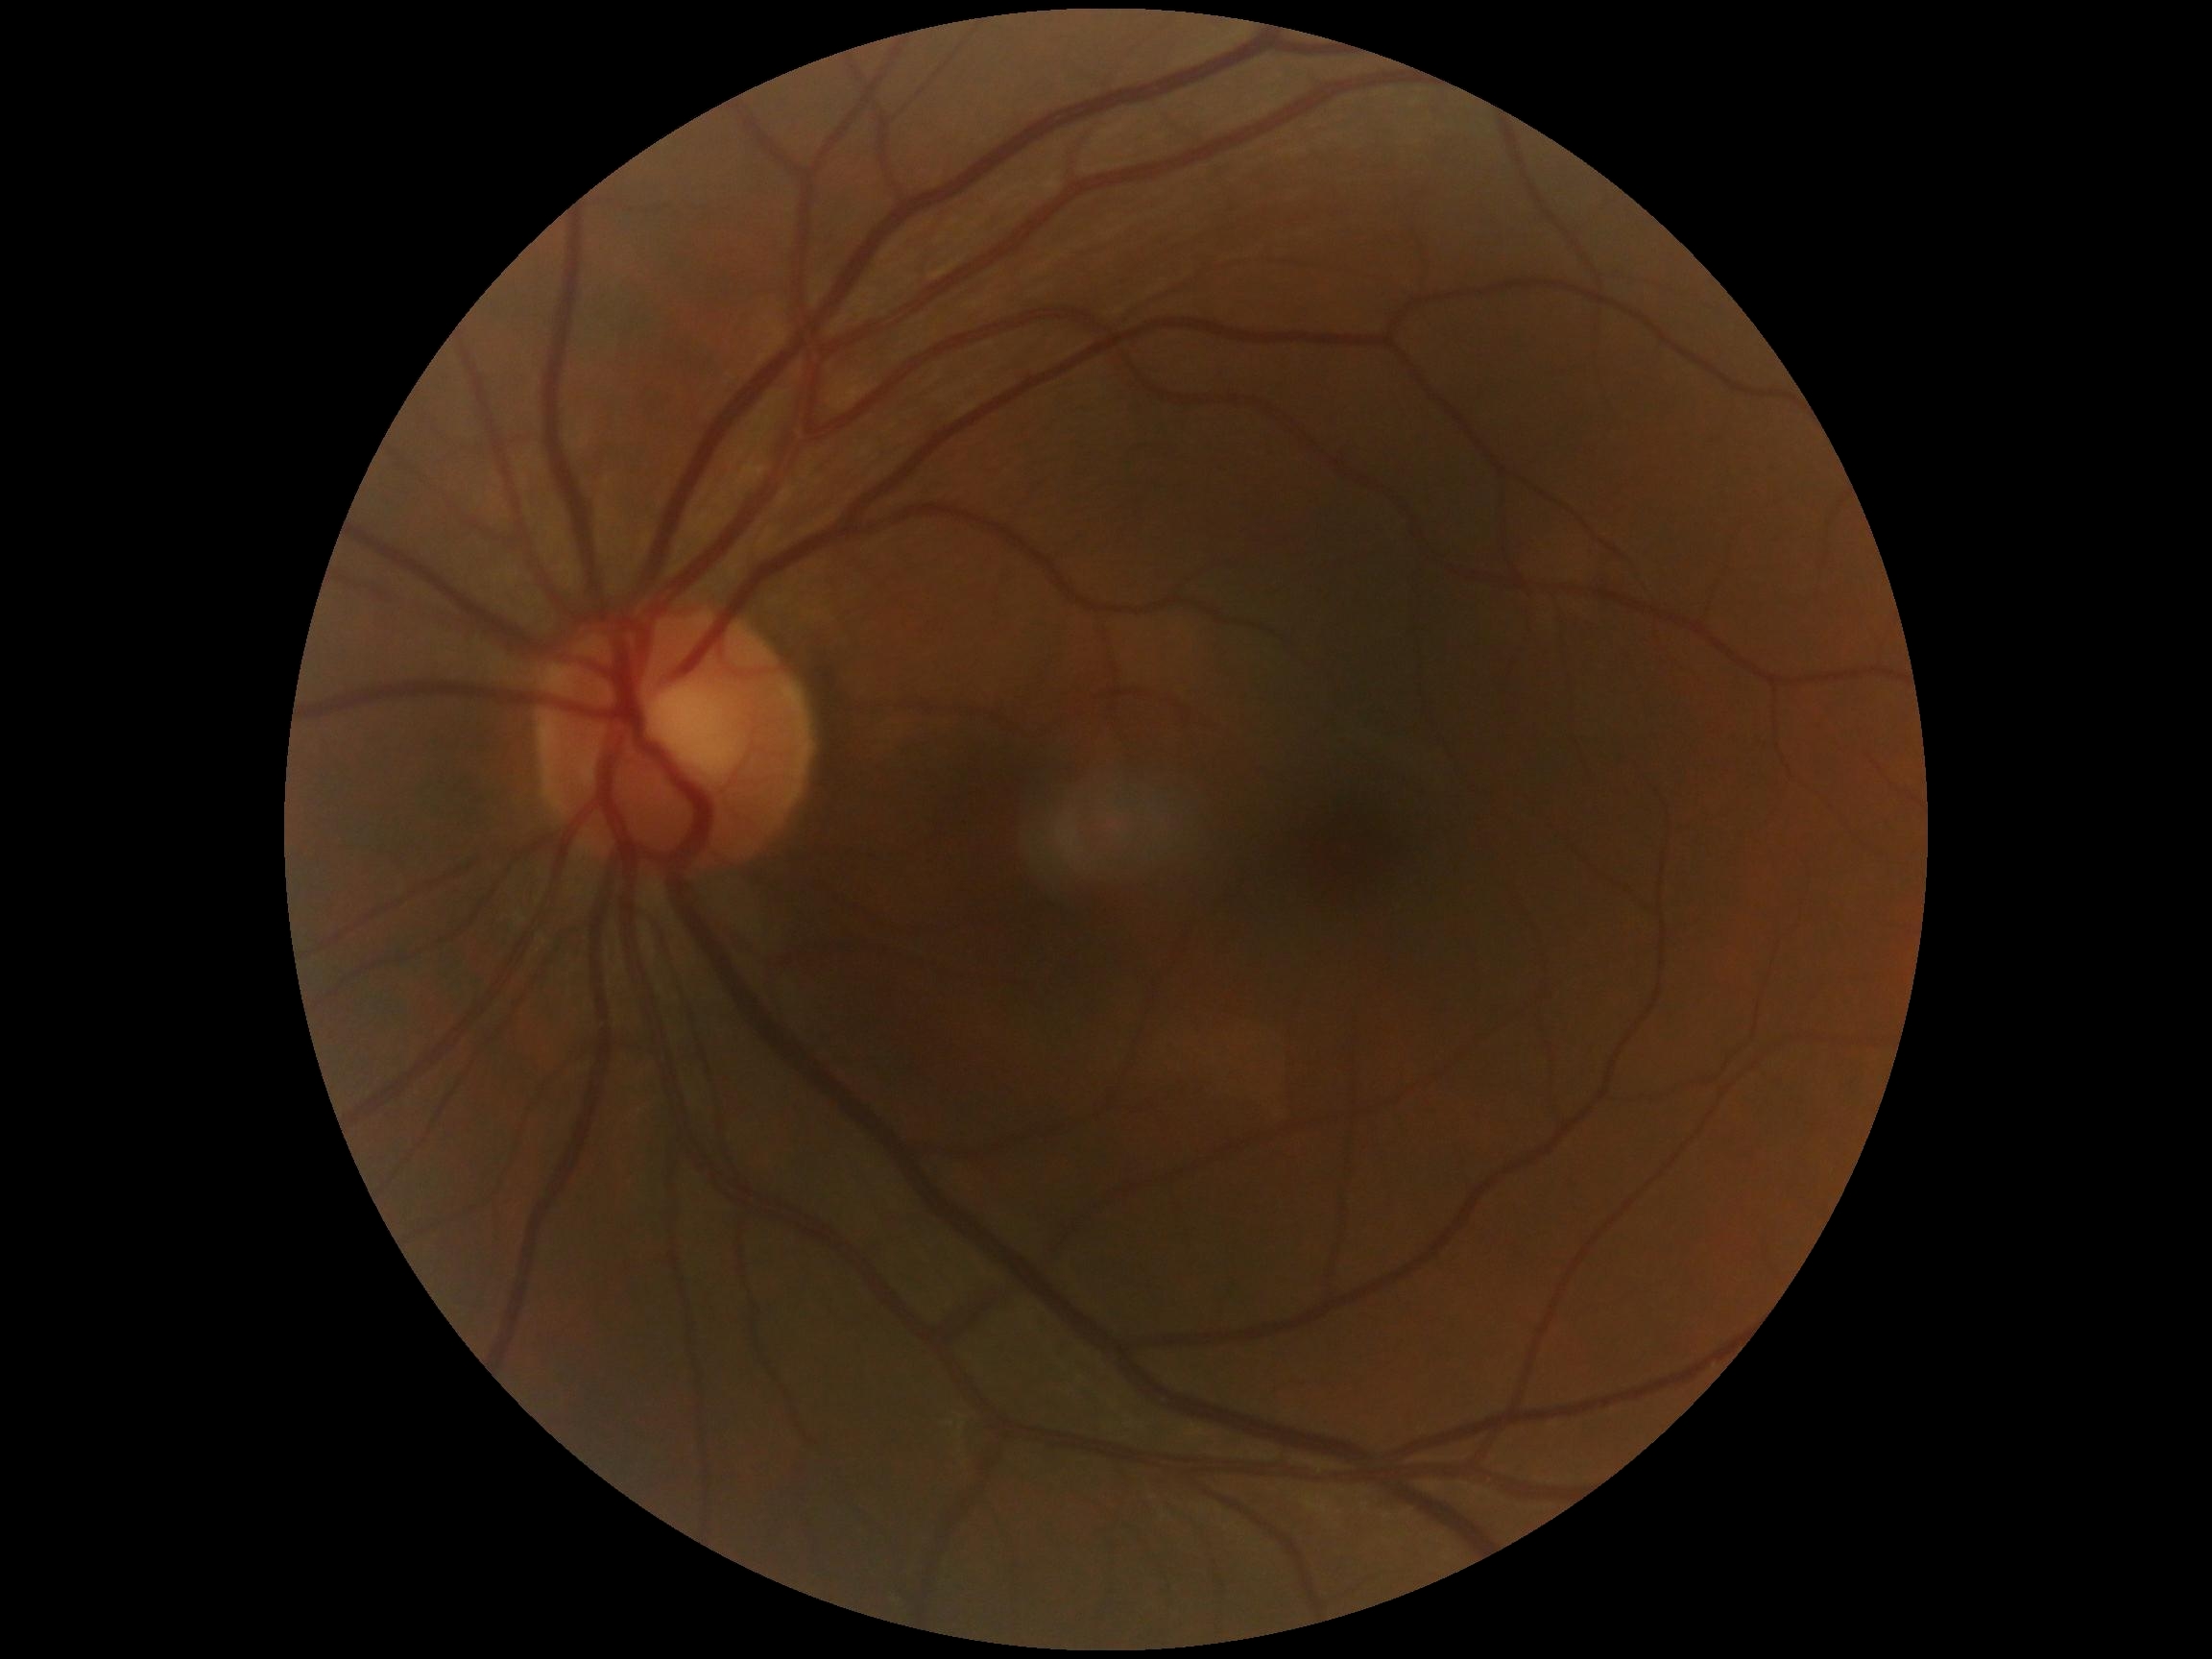
DR severity: 0.
No signs of diabetic retinopathy.